Color fundus photograph: 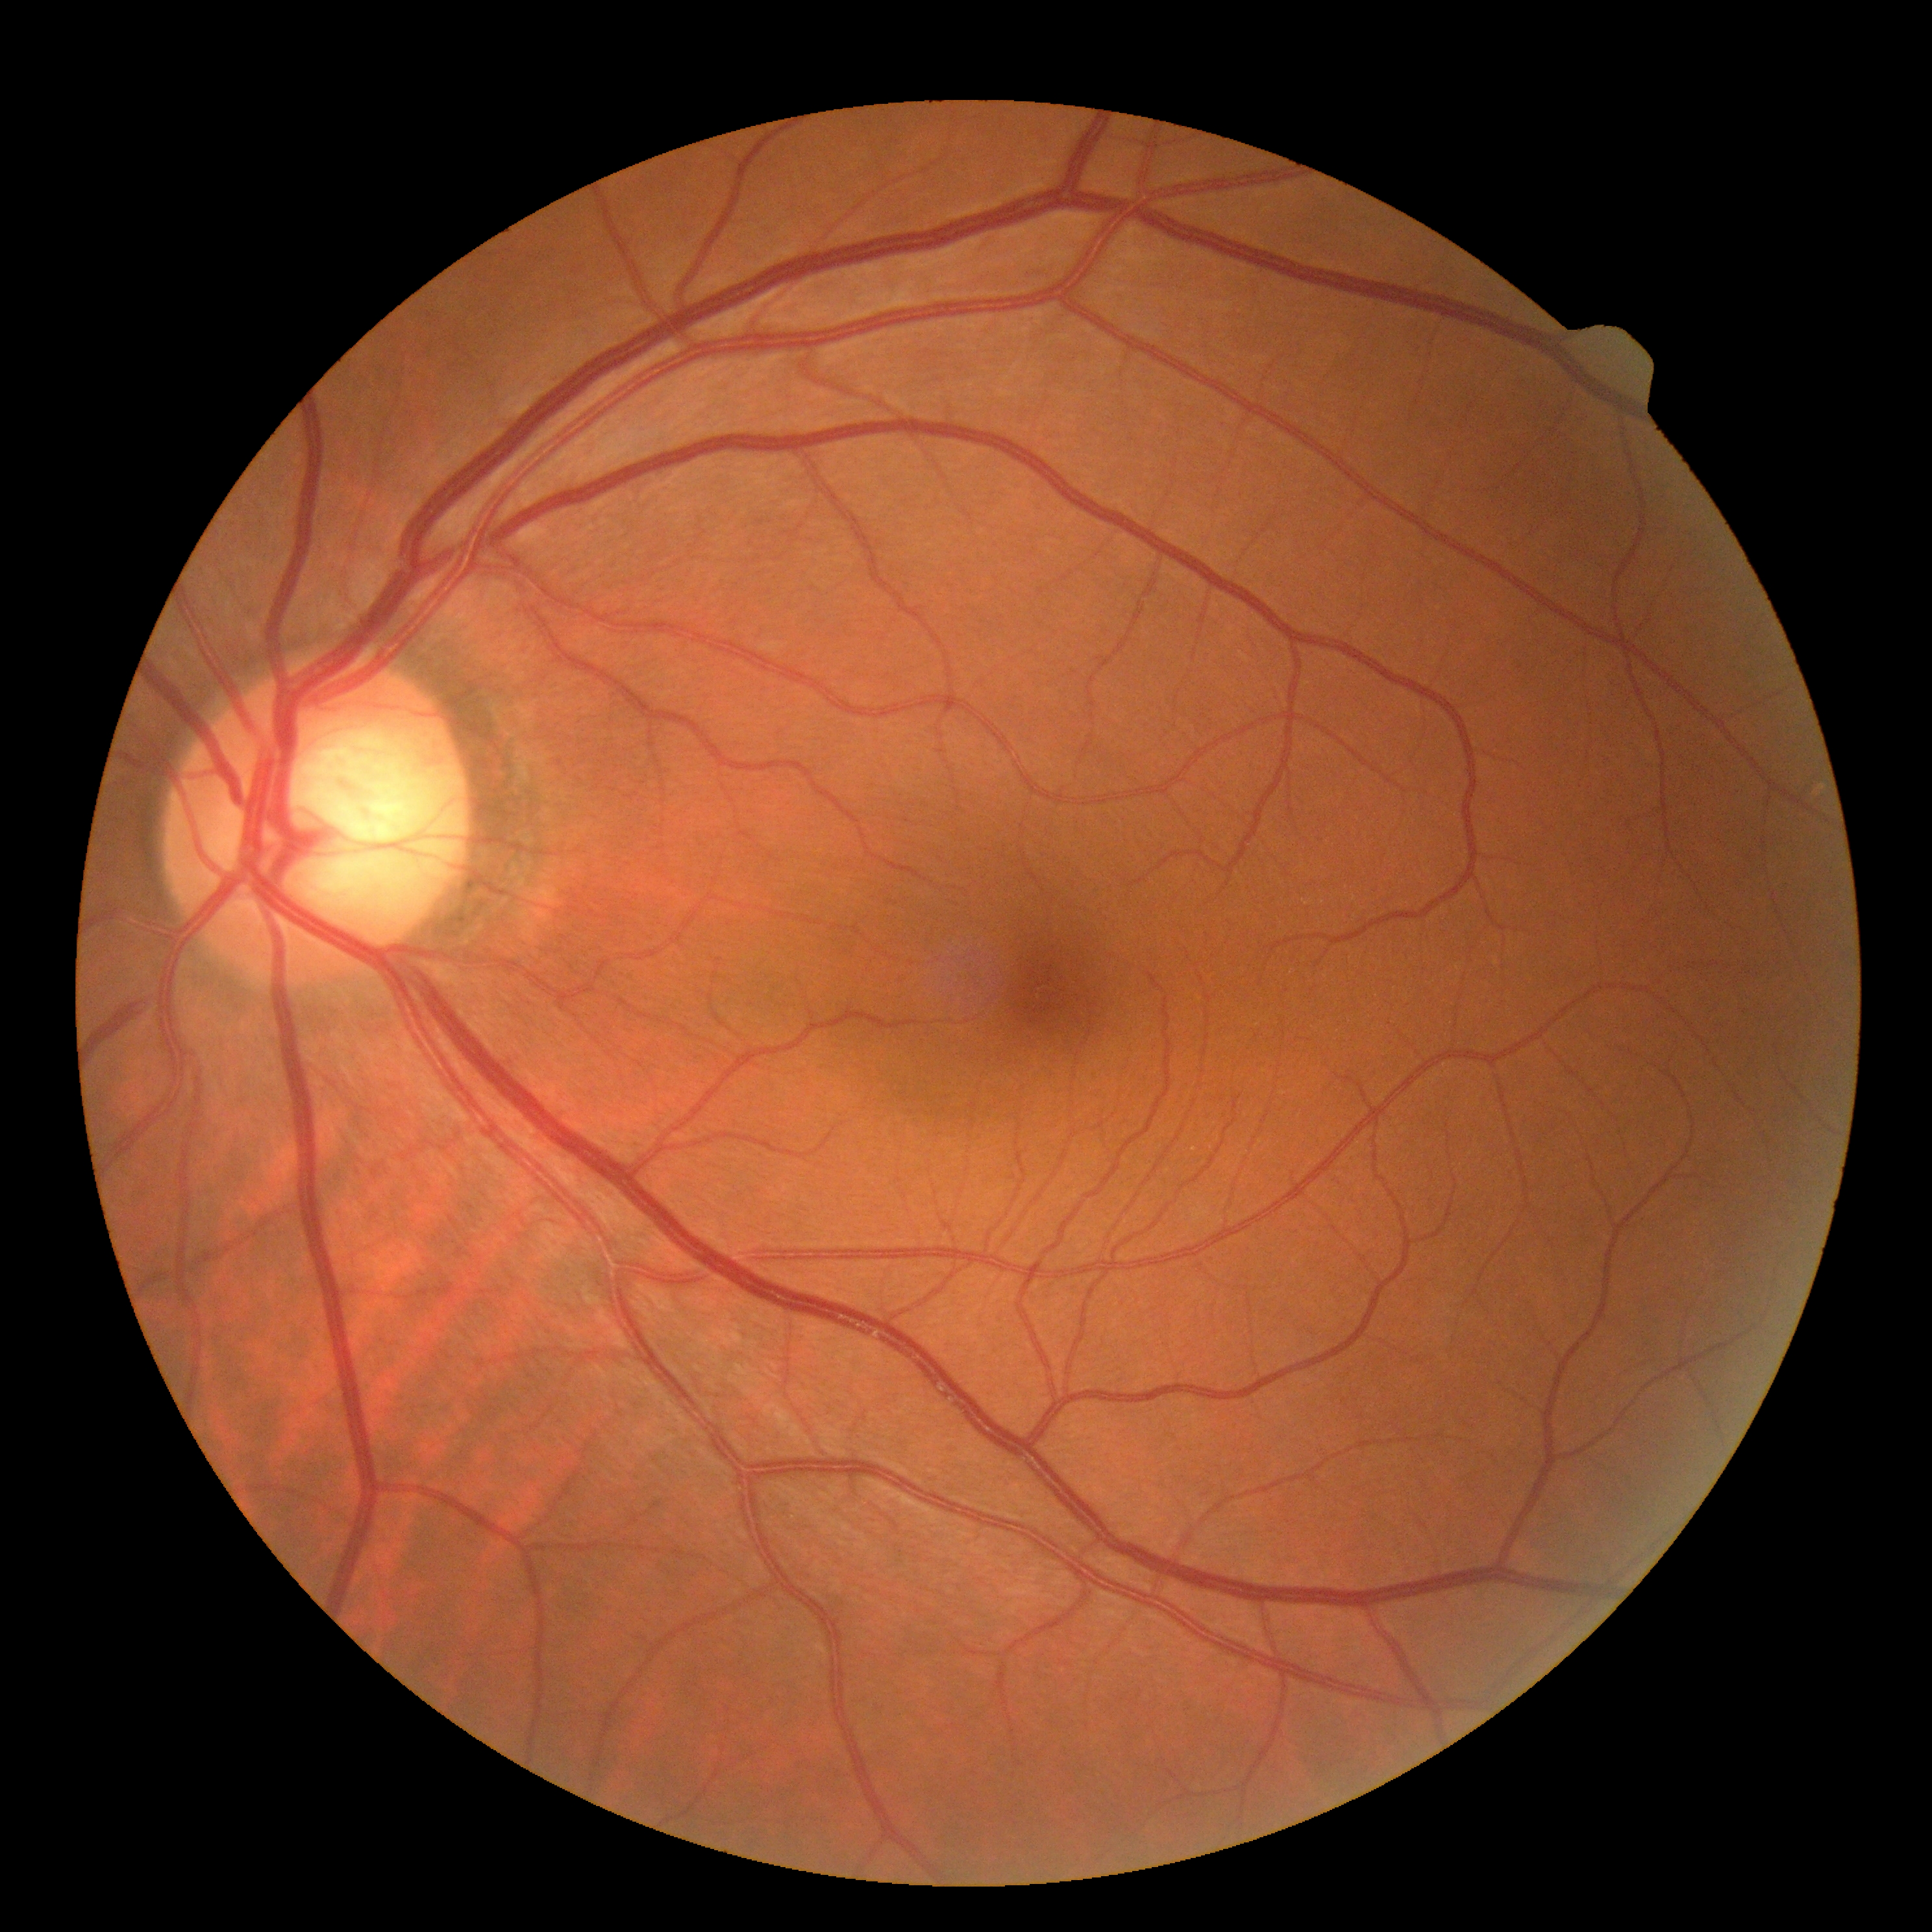 DR stage@grade 0 (no apparent retinopathy).